DR severity per modified Davis staging. 848x848px. 45° FOV. Acquired with a NIDEK AFC-230.
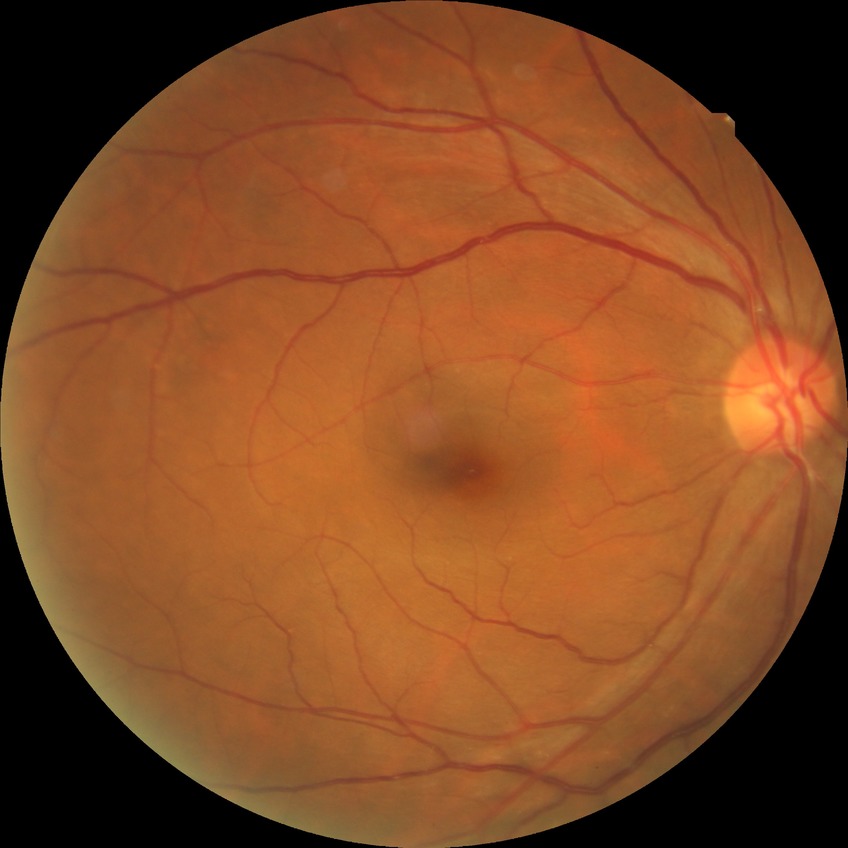

Diabetic retinopathy (DR) is no diabetic retinopathy (NDR).